100° field of view (Phoenix ICON). Pediatric retinal photograph (wide-field): 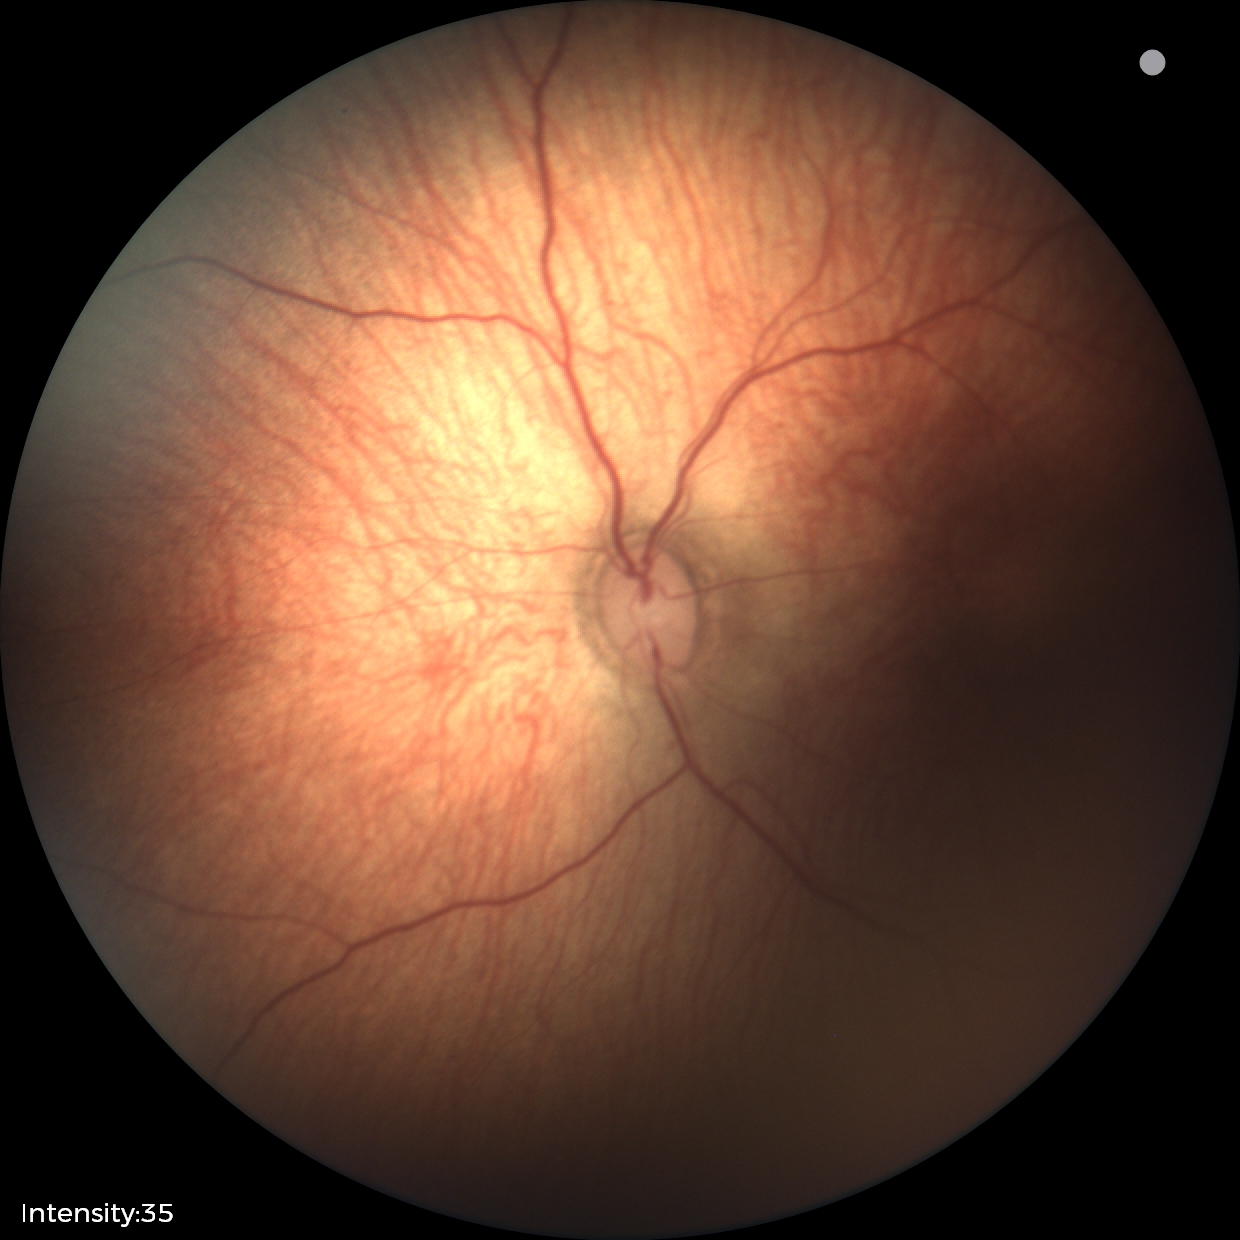

Impression: status post retinopathy of prematurity — retinal appearance after treated retinopathy of prematurity; no plus disease.